Retinal fundus photograph; 2048x1536; 45° field of view
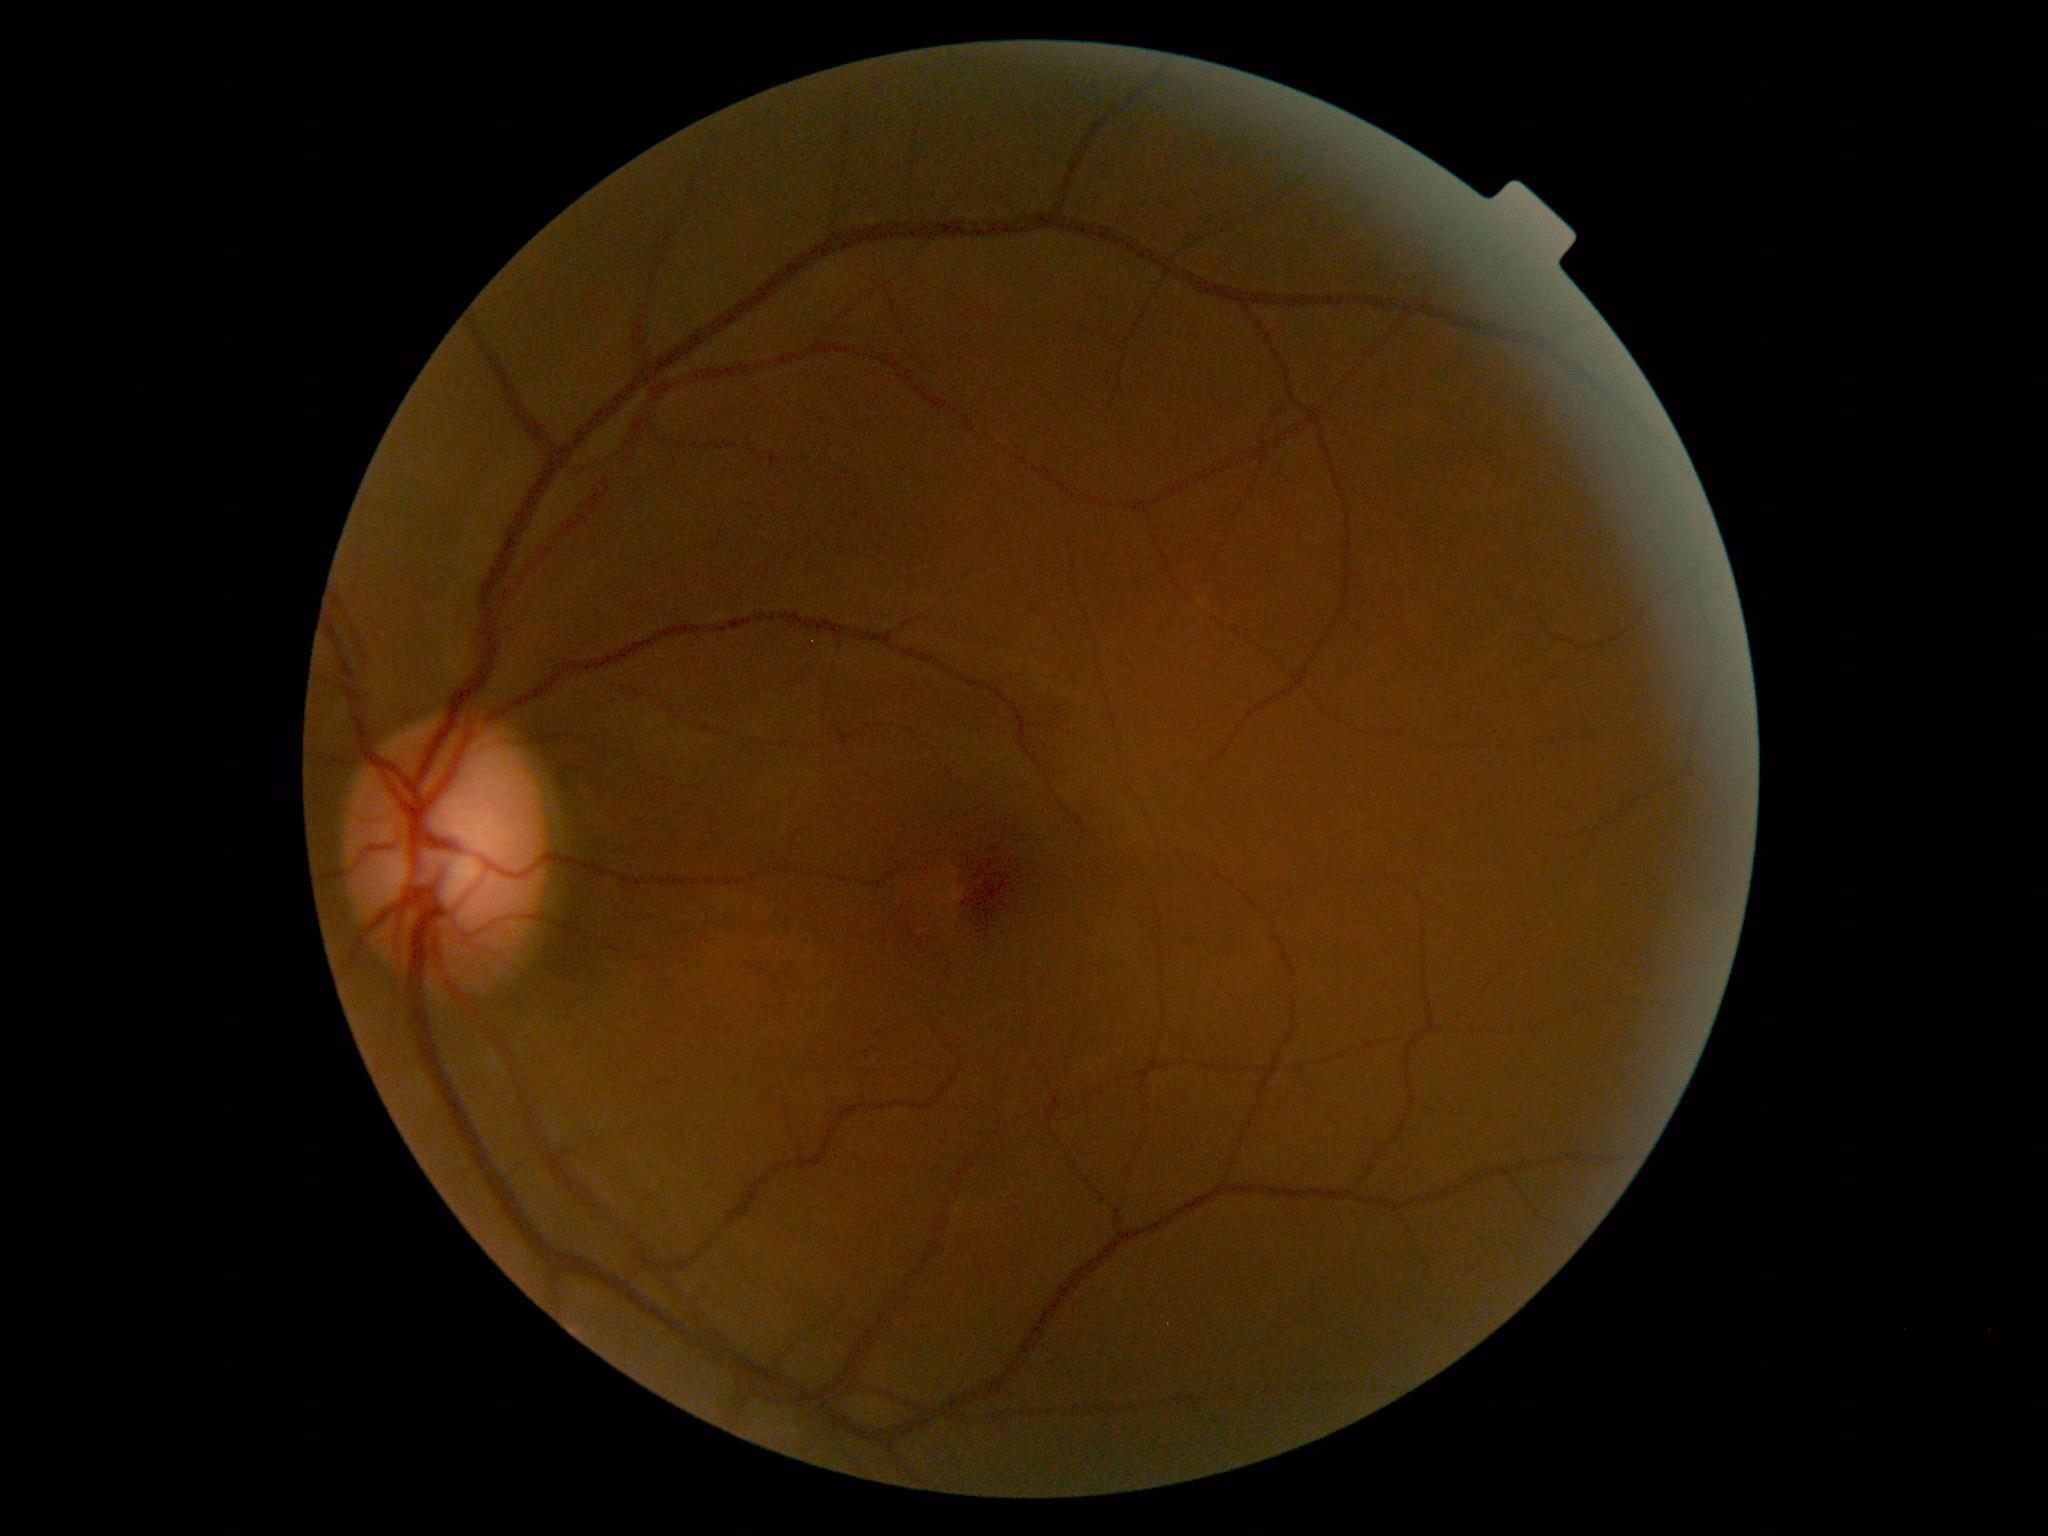
Findings:
* DR: mild non-proliferative diabetic retinopathy (grade 1)